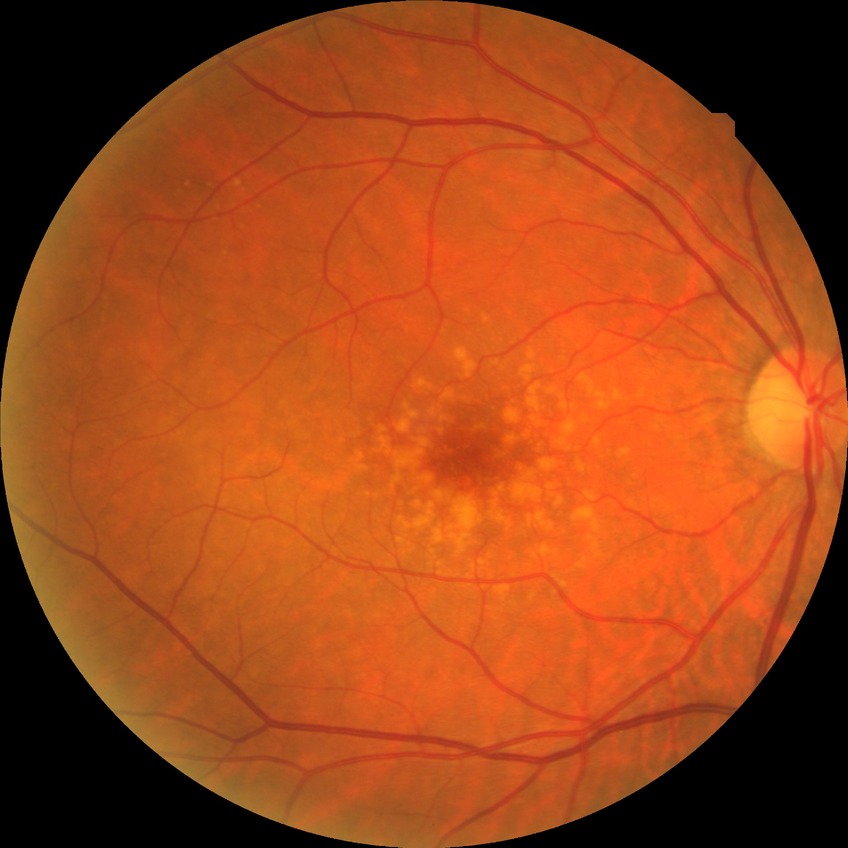 DR is NDR.